1380x1382:
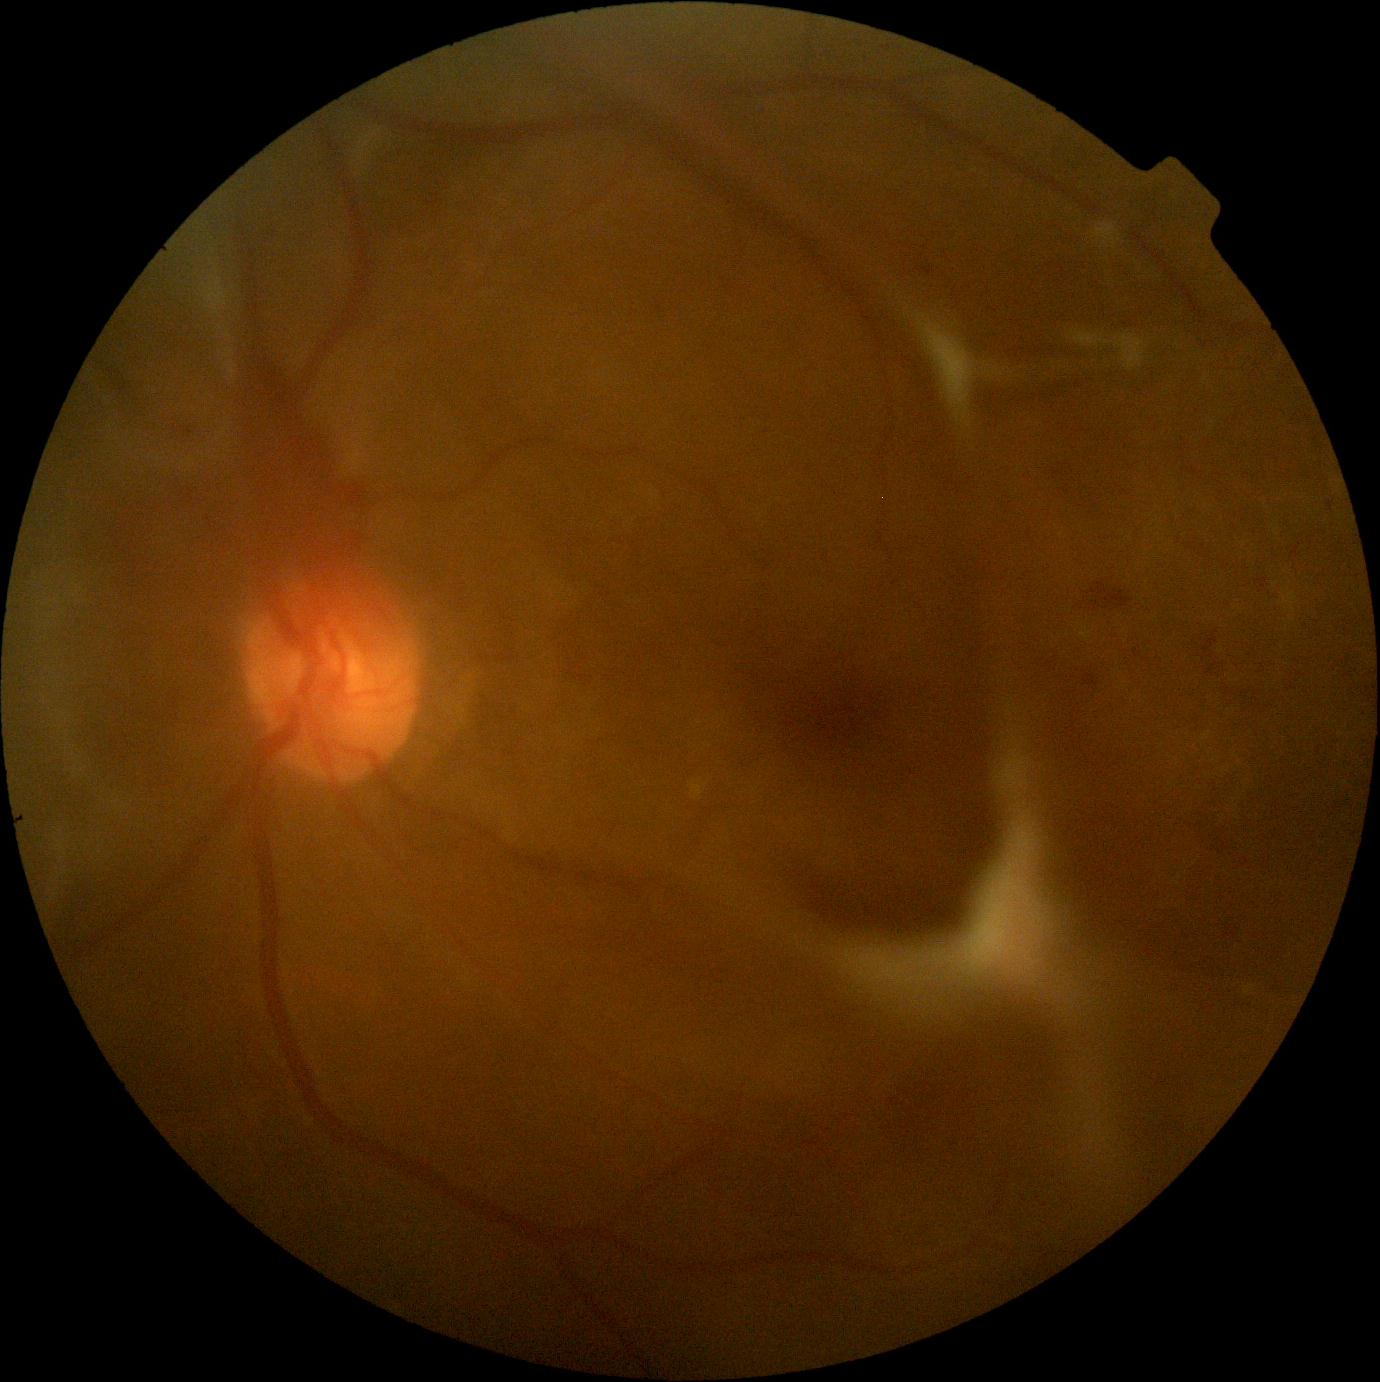

Diabetic retinopathy grade is 4 (PDR).